CFP
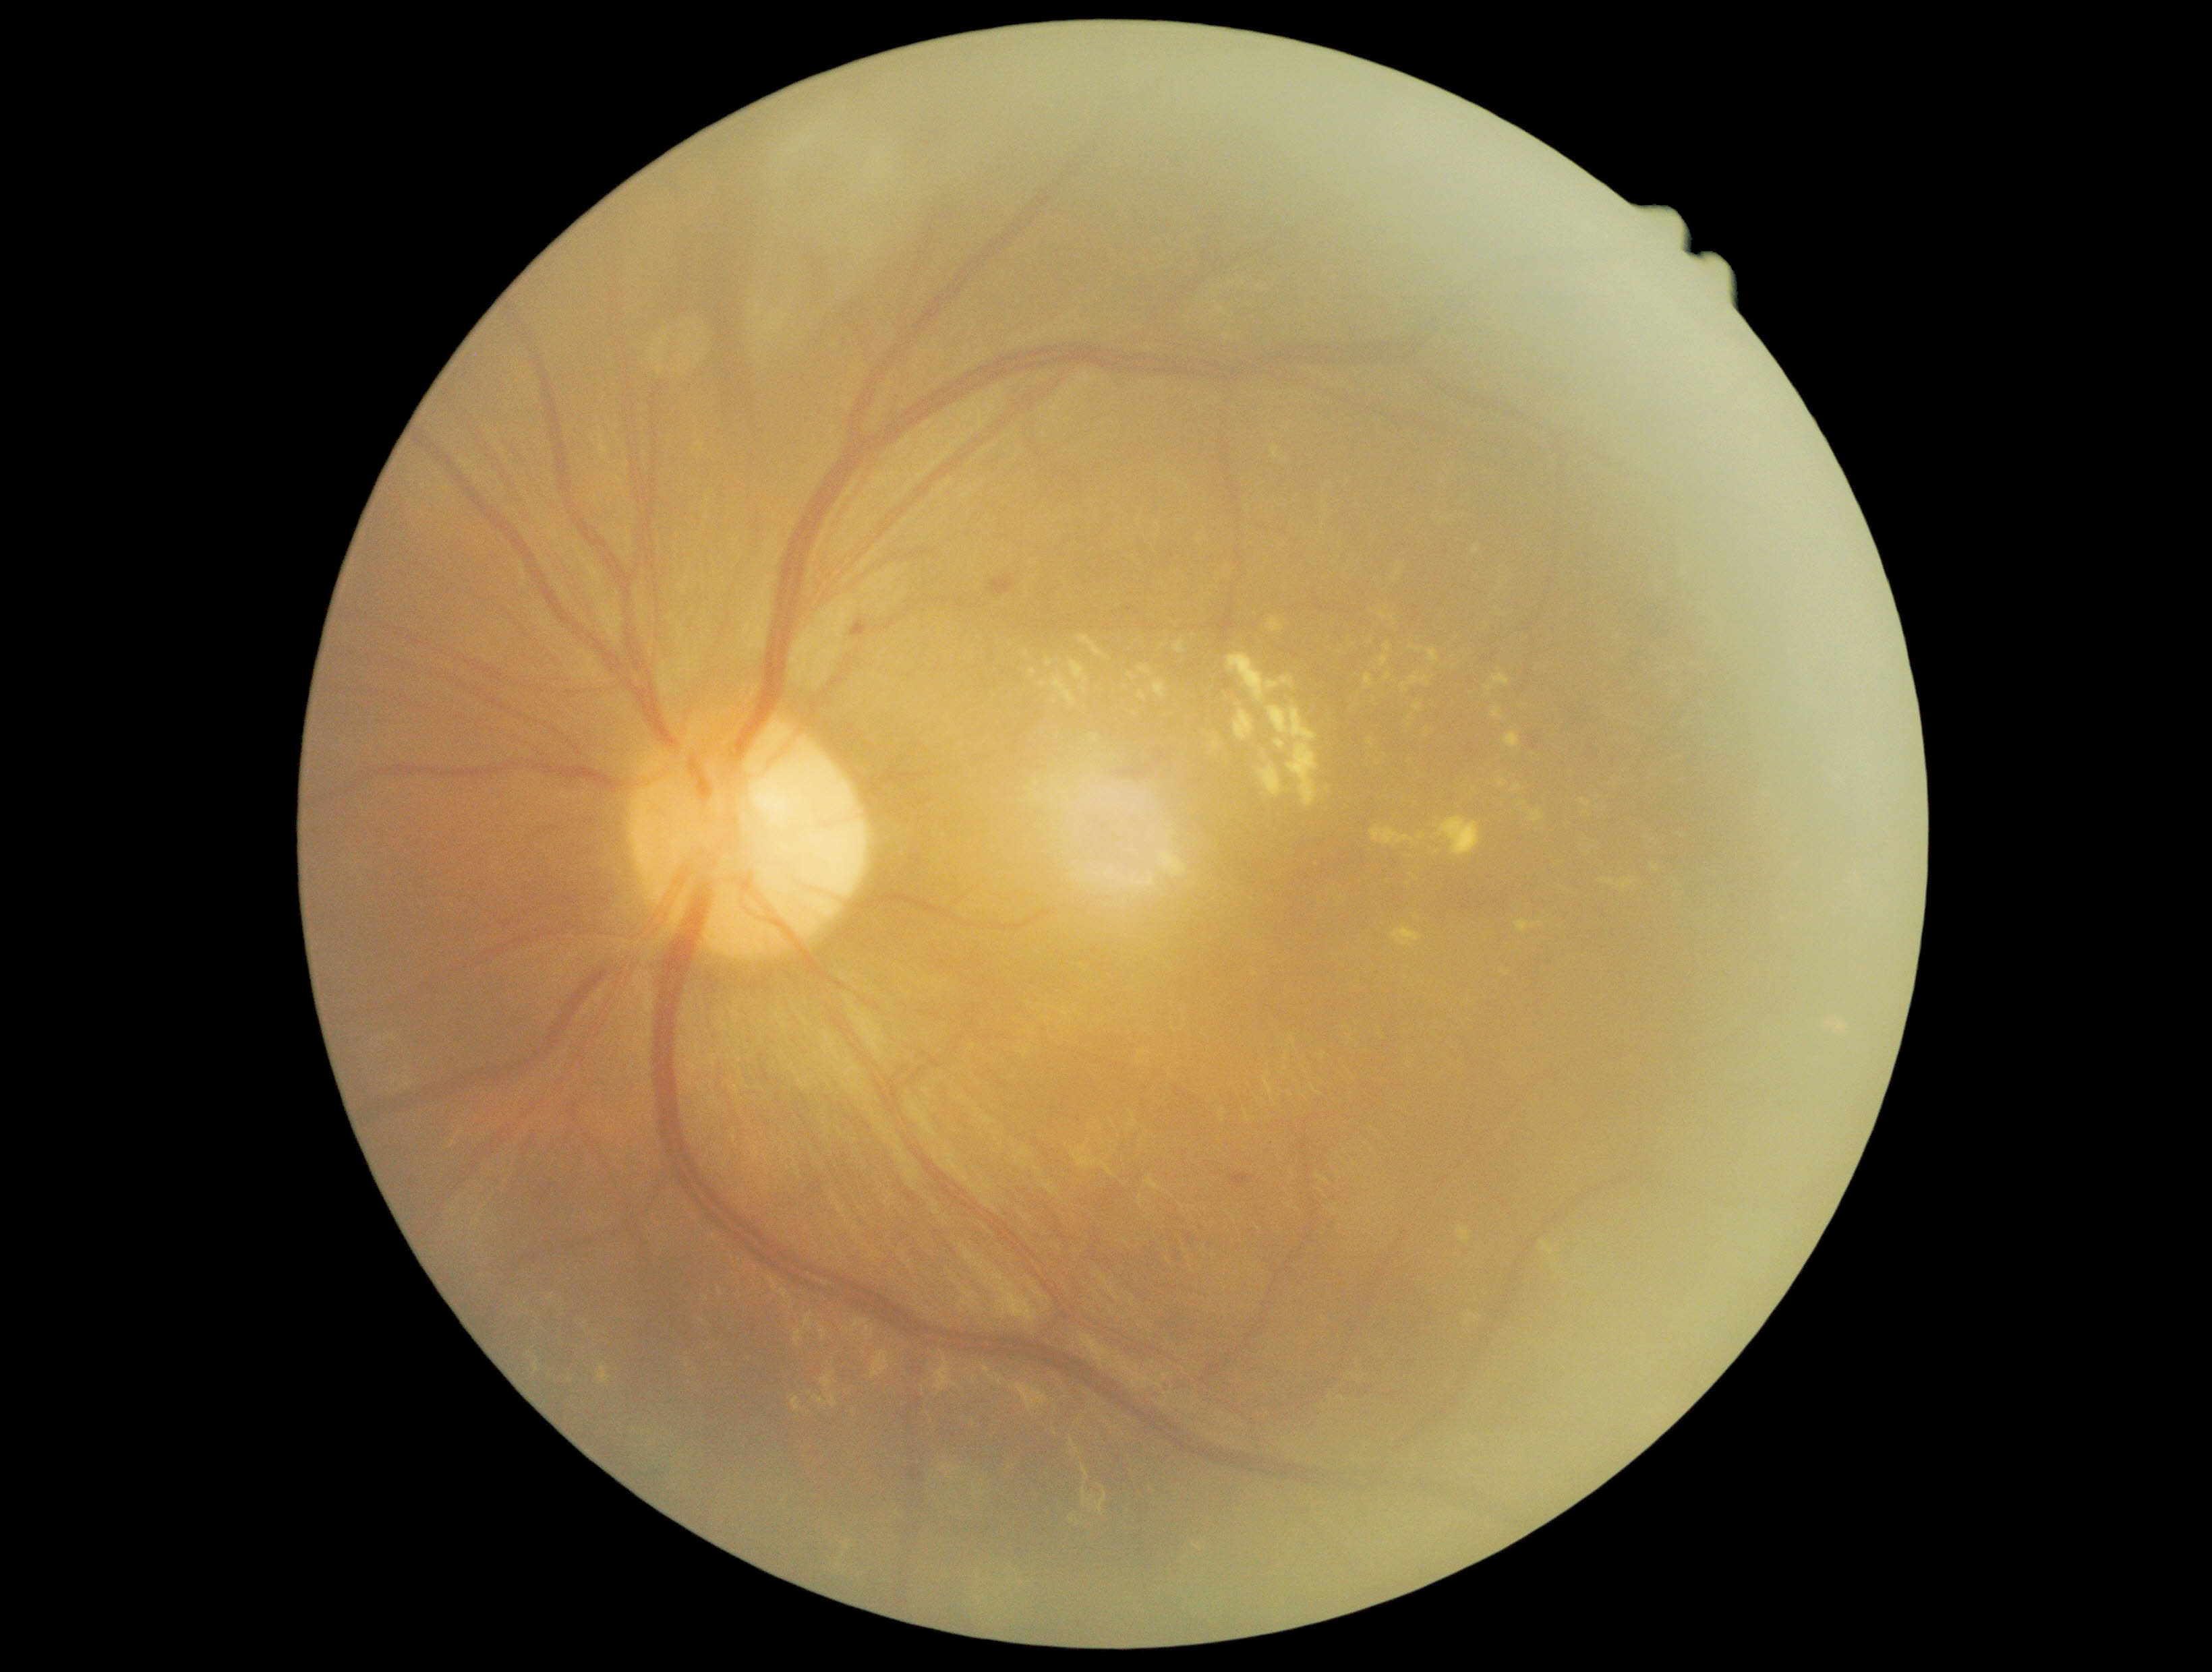
Diabetic retinopathy (DR) is 2.